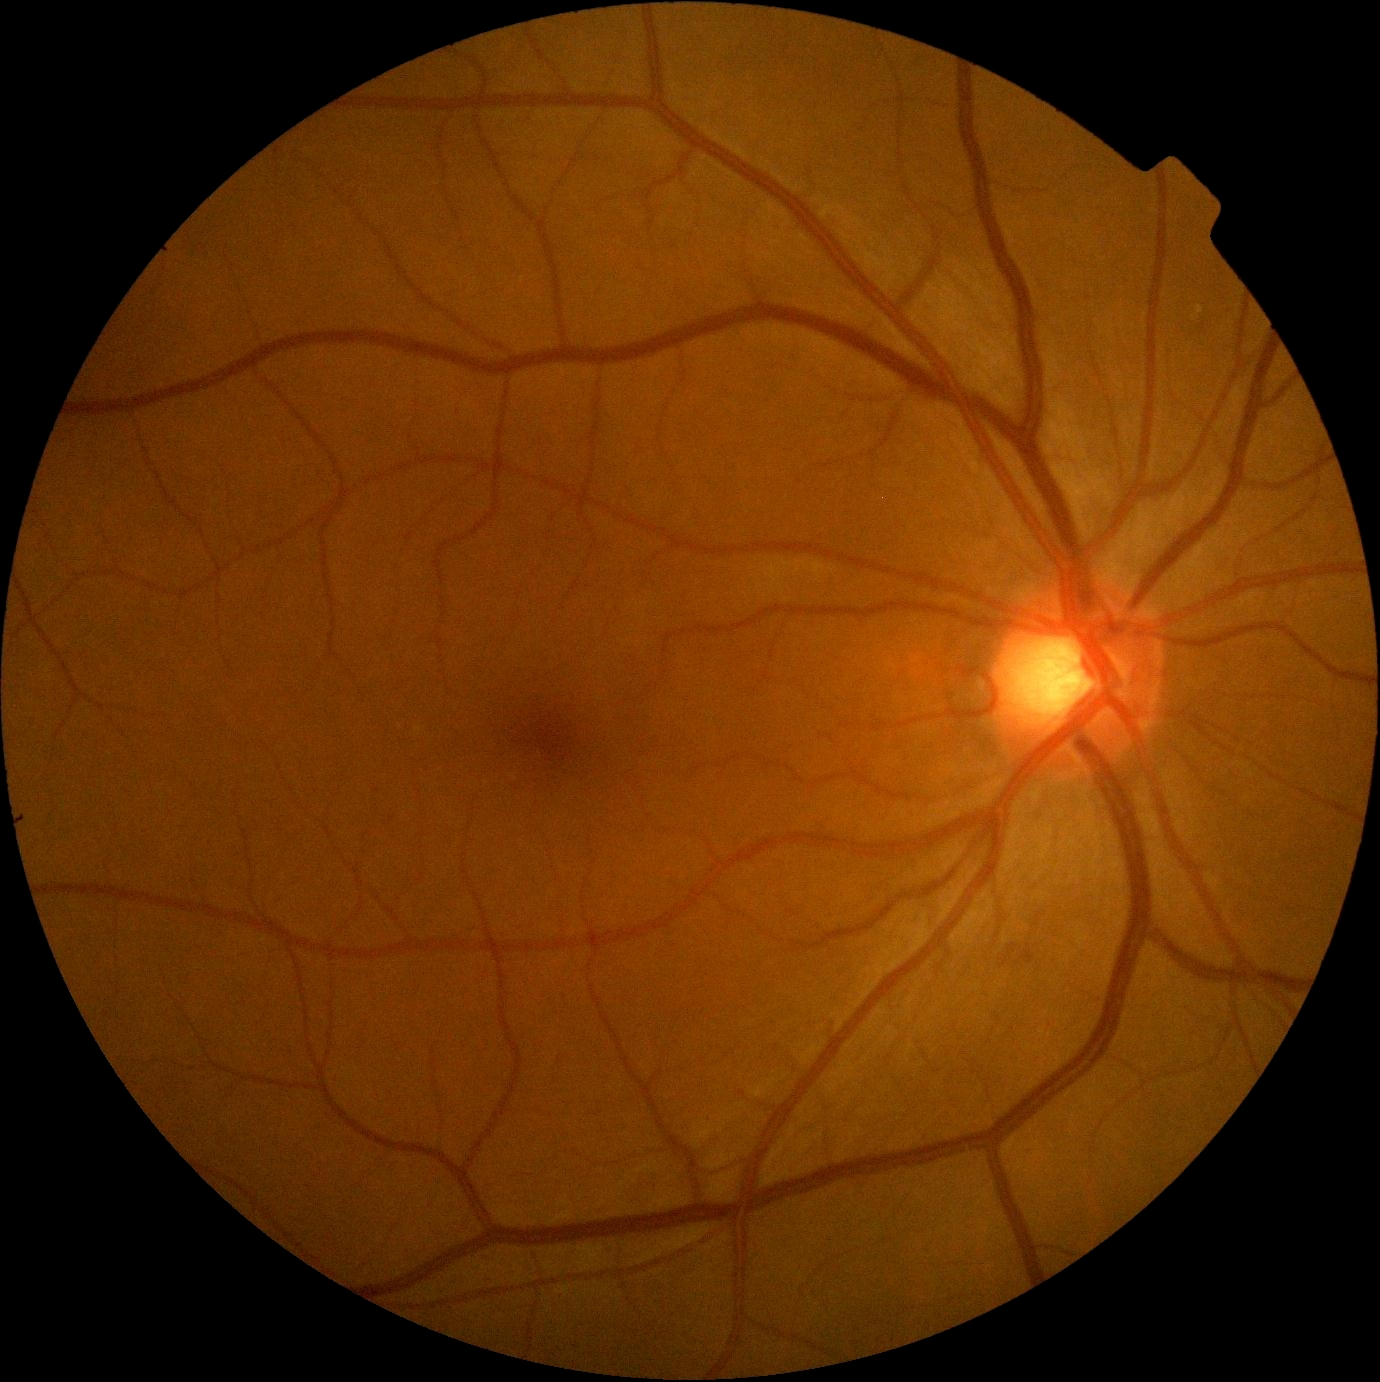 diabetic retinopathy (DR)=0; DR impression=negative for DR.